Wide-field contact fundus photograph of an infant:
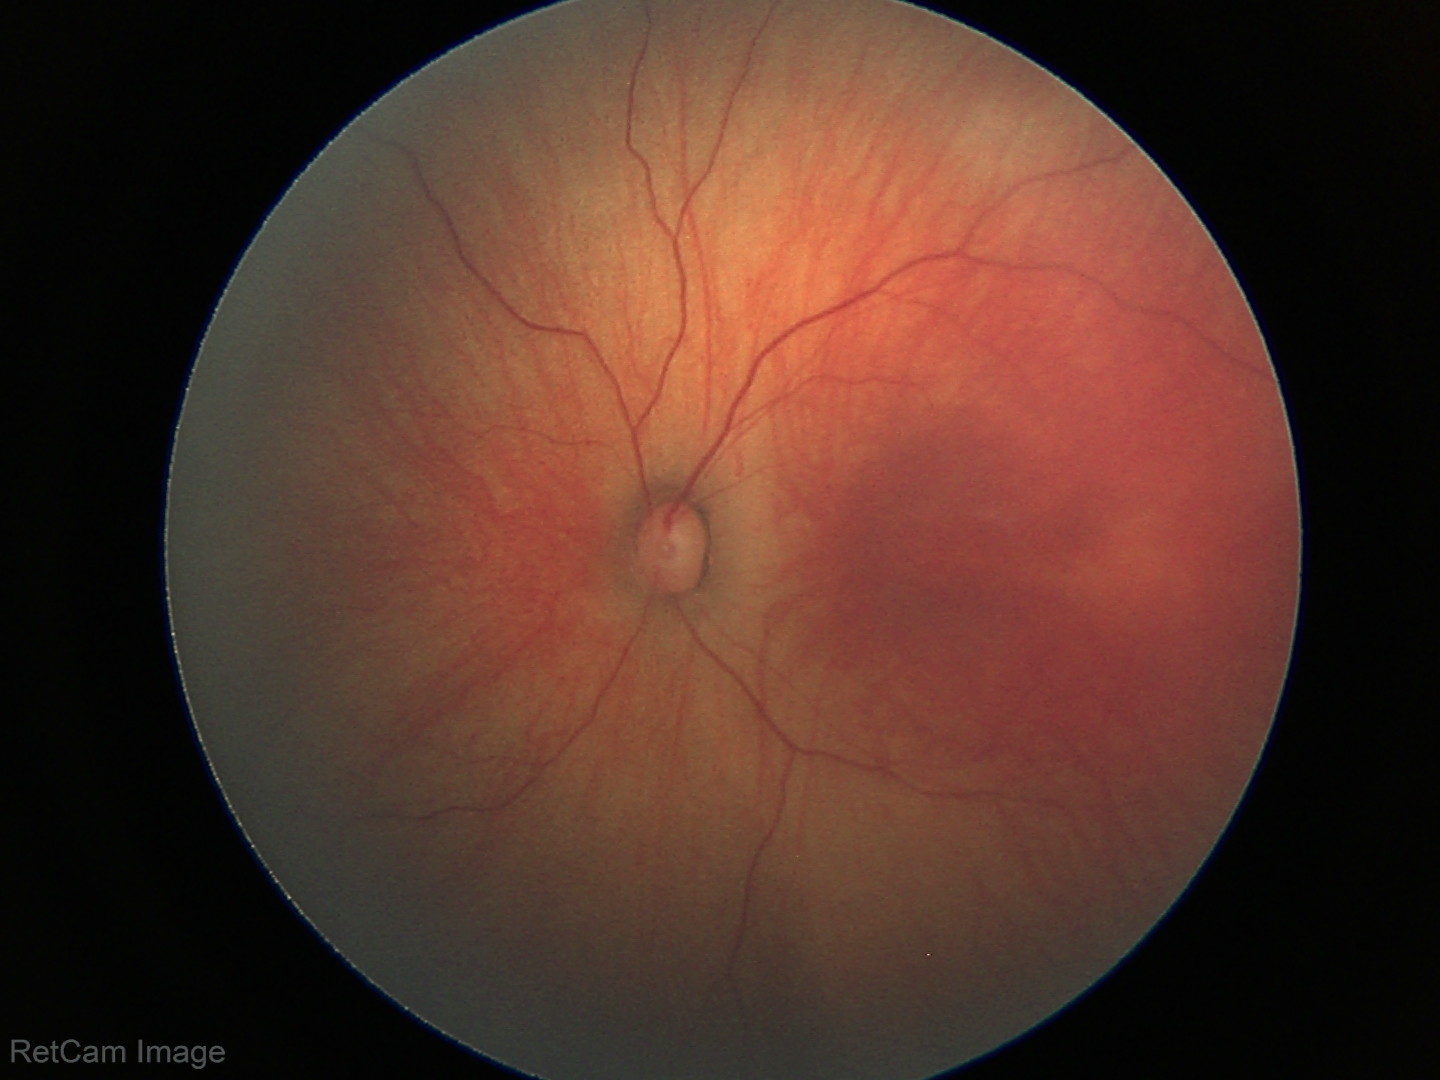

Screening diagnosis: physiological appearance with no retinal pathology.